2048x1536px
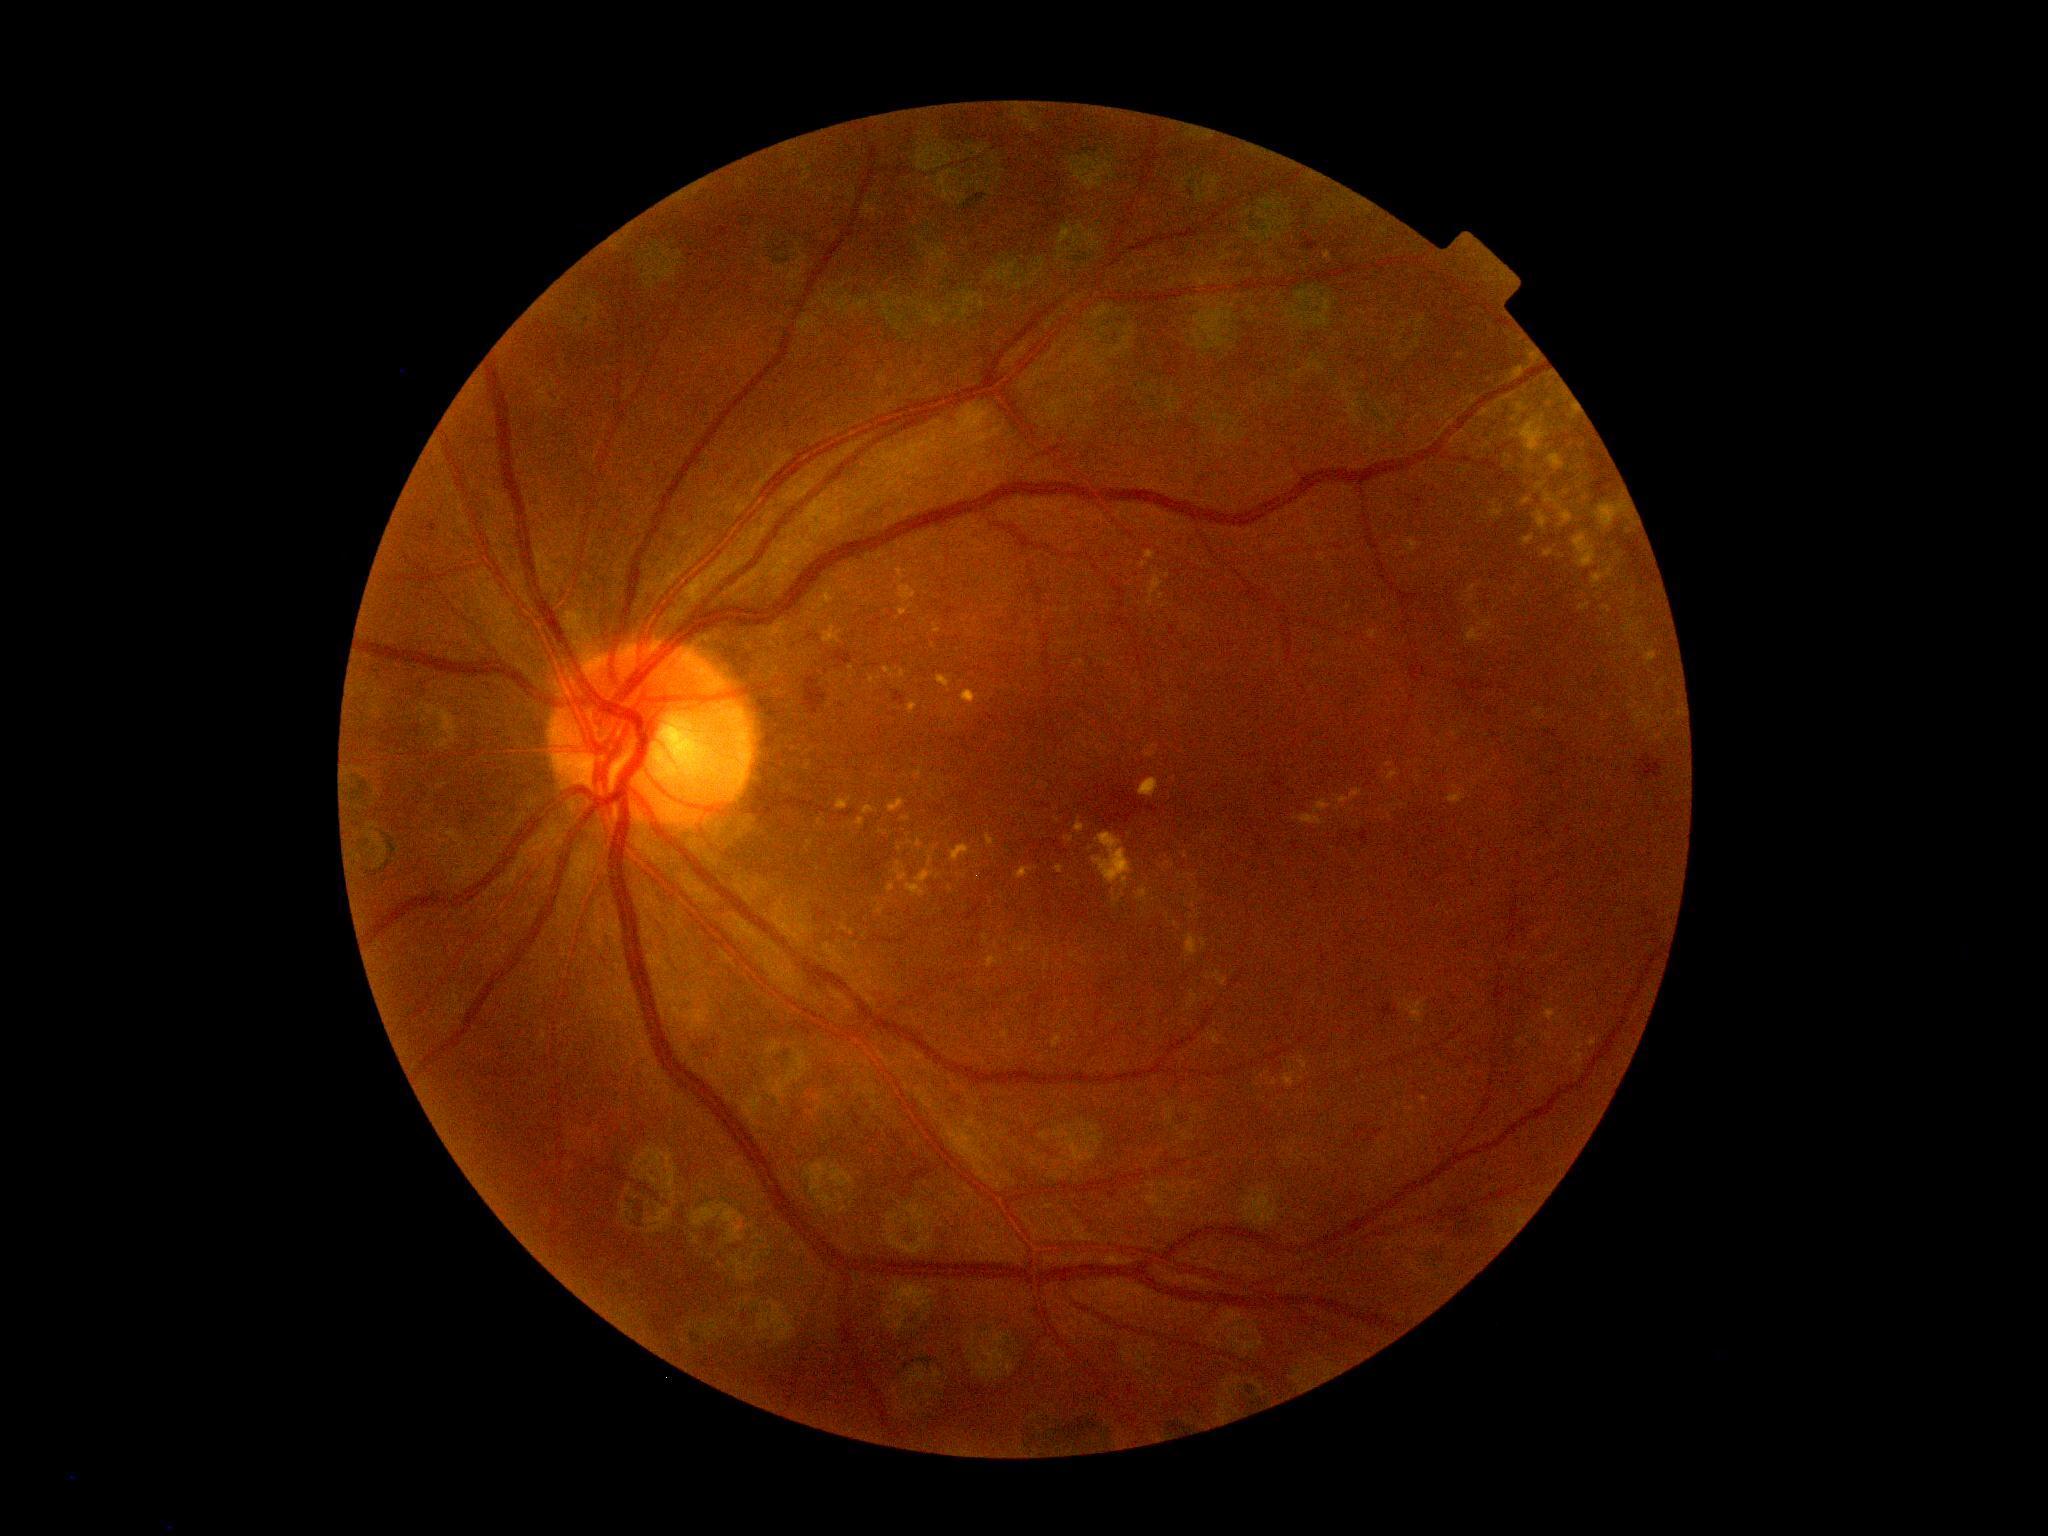 DR stage is moderate non-proliferative diabetic retinopathy (grade 2).
Disease class: non-proliferative diabetic retinopathy.